CFP
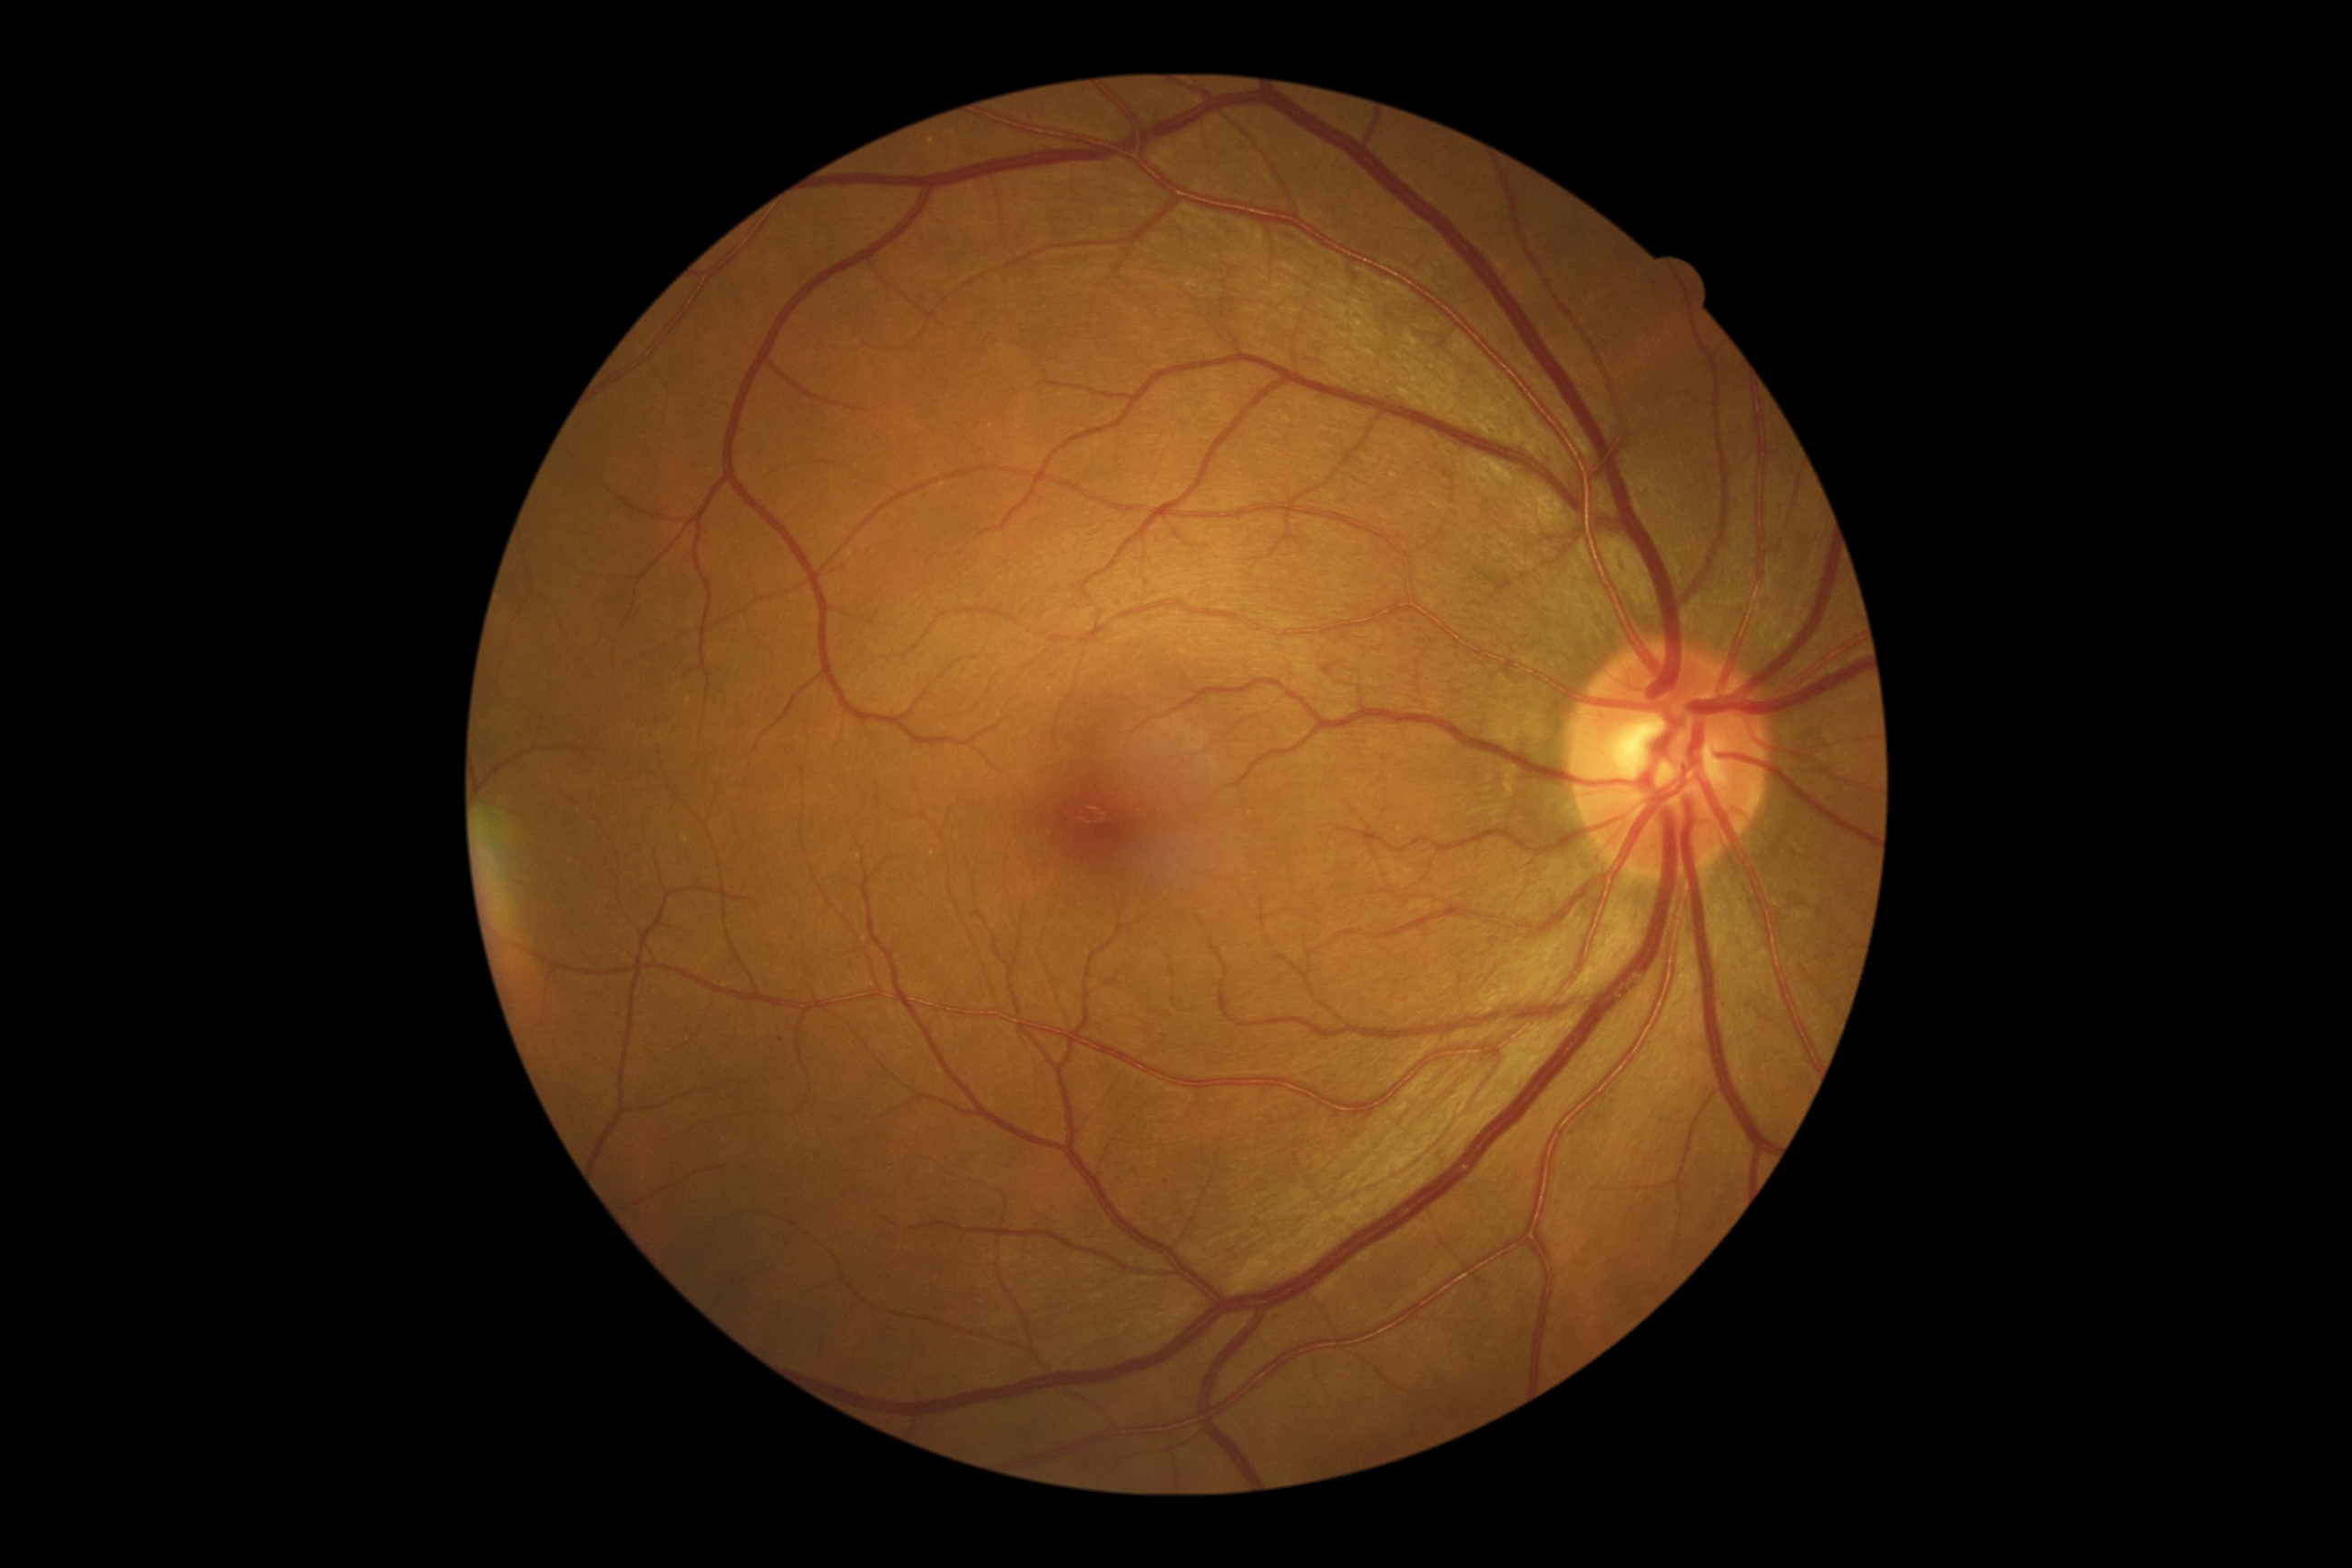
DR class: non-proliferative diabetic retinopathy, DR: grade 1 (mild NPDR).